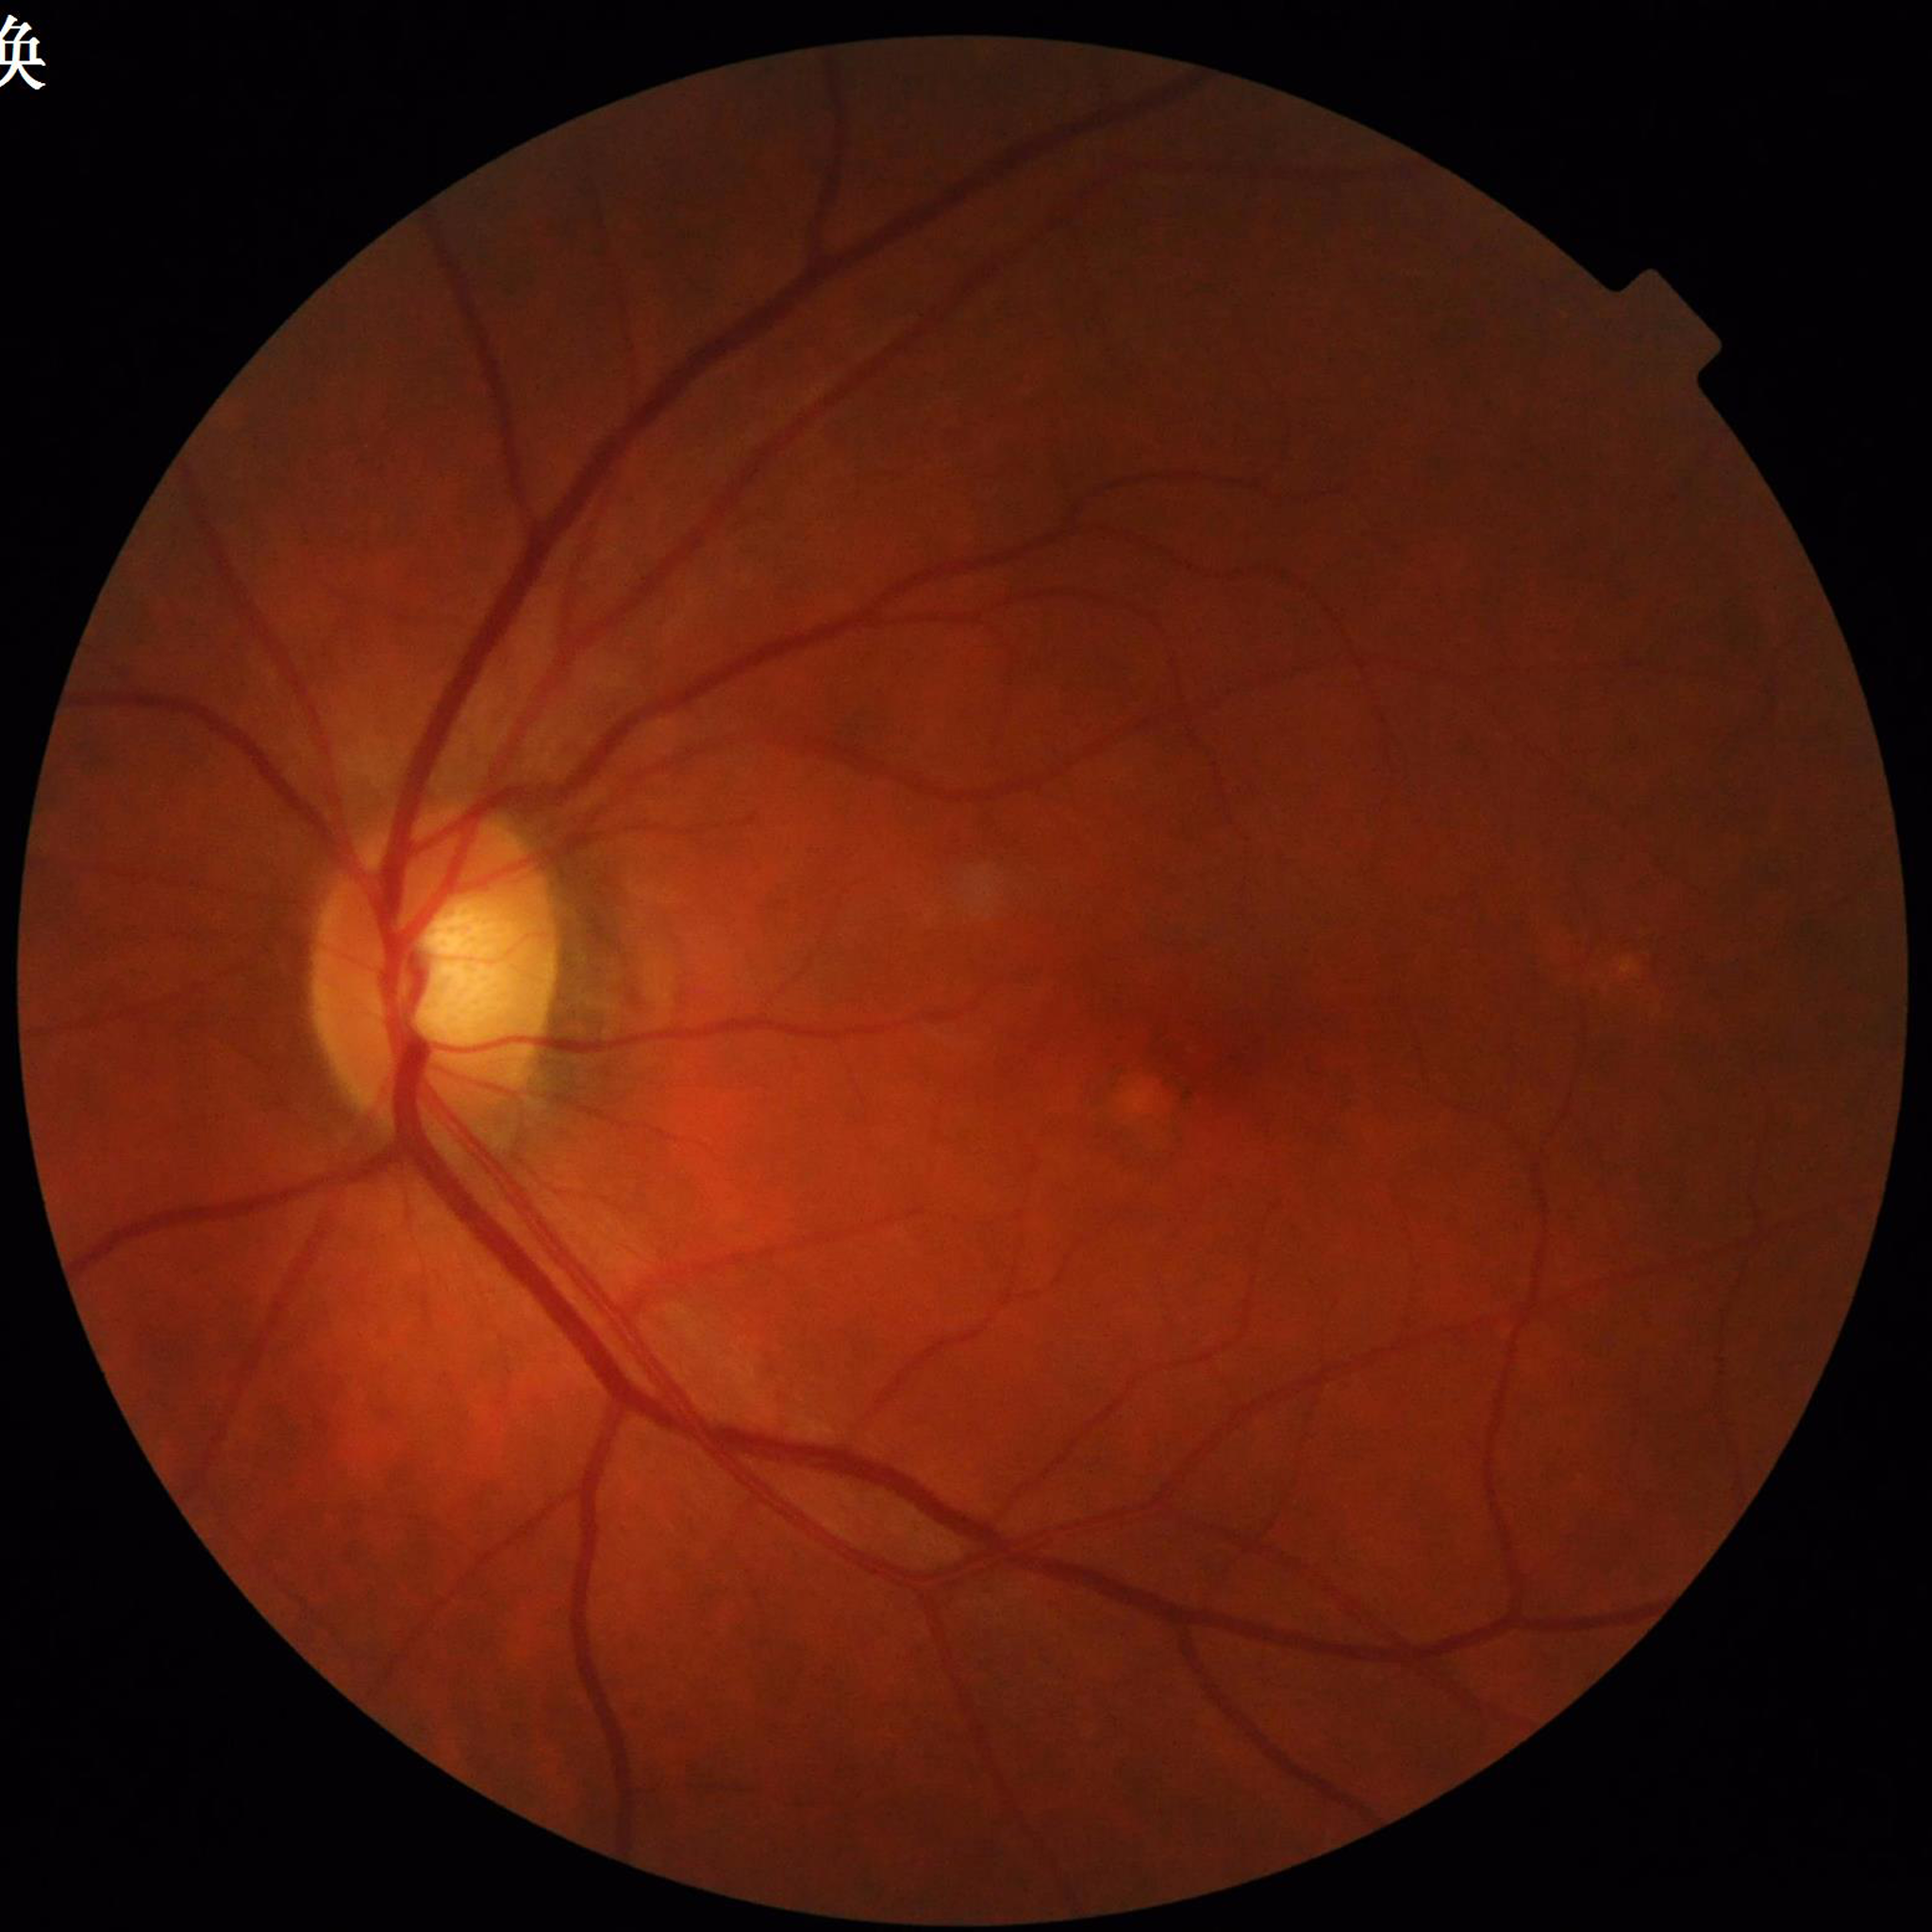 This fundus photograph is from a patient diagnosed with age-related macular degeneration.